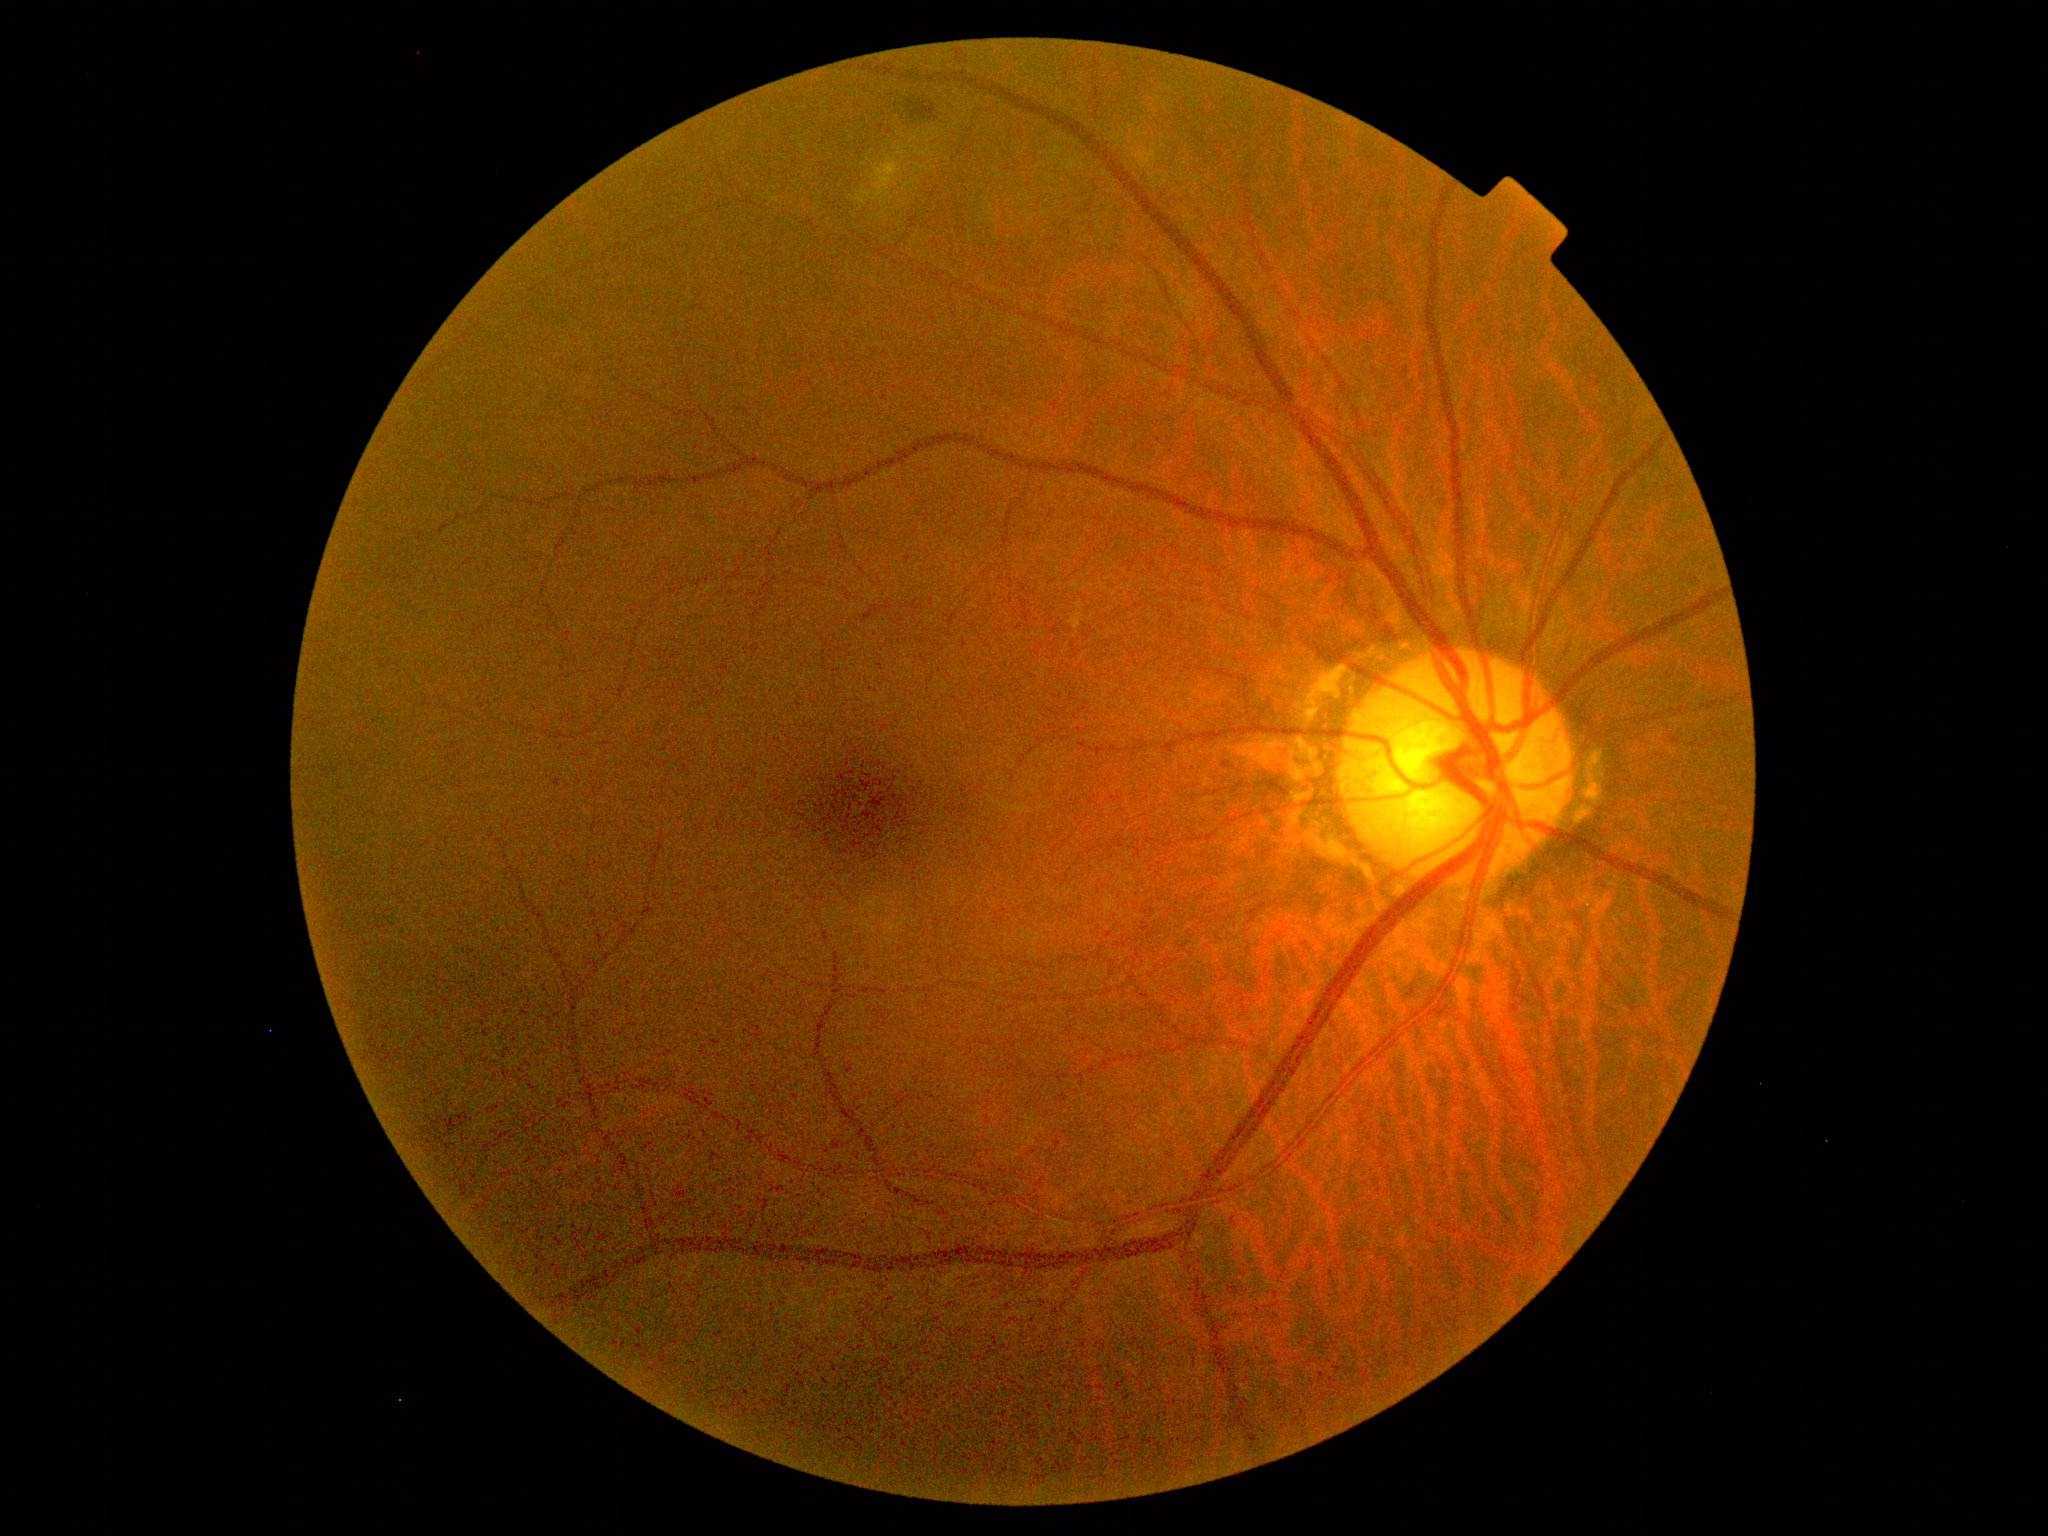
DR severity is 2.